45-degree field of view, NIDEK AFC-230 fundus camera: 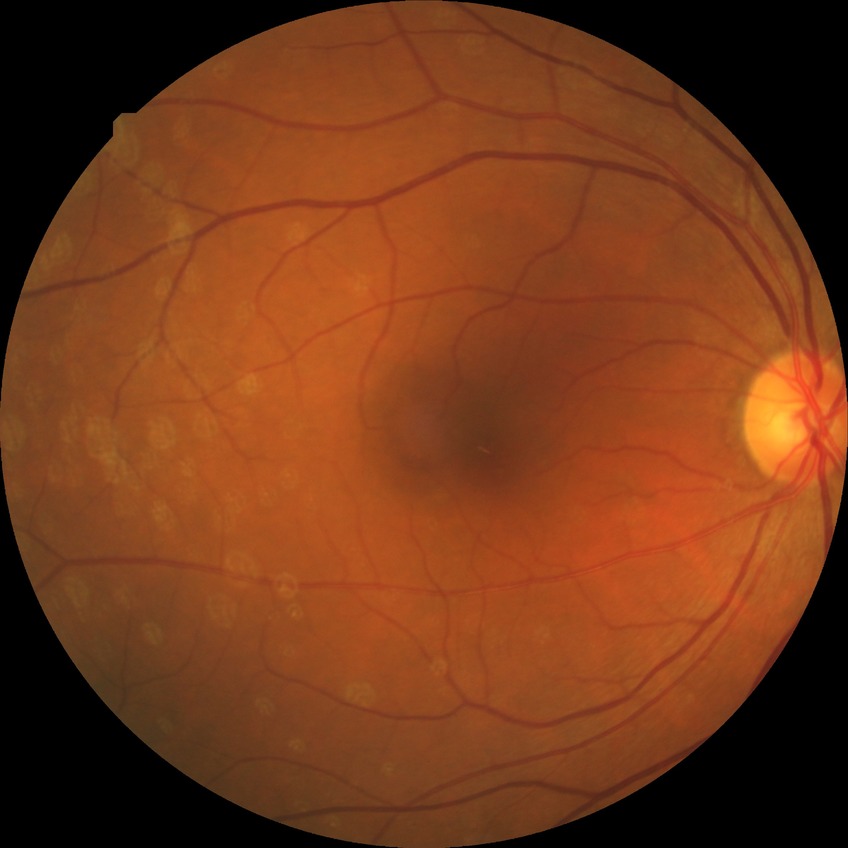 Diabetic retinopathy (DR) is NDR (no diabetic retinopathy).